UWF retinal mosaic. 200° field of view. 1924 by 1556 pixels:
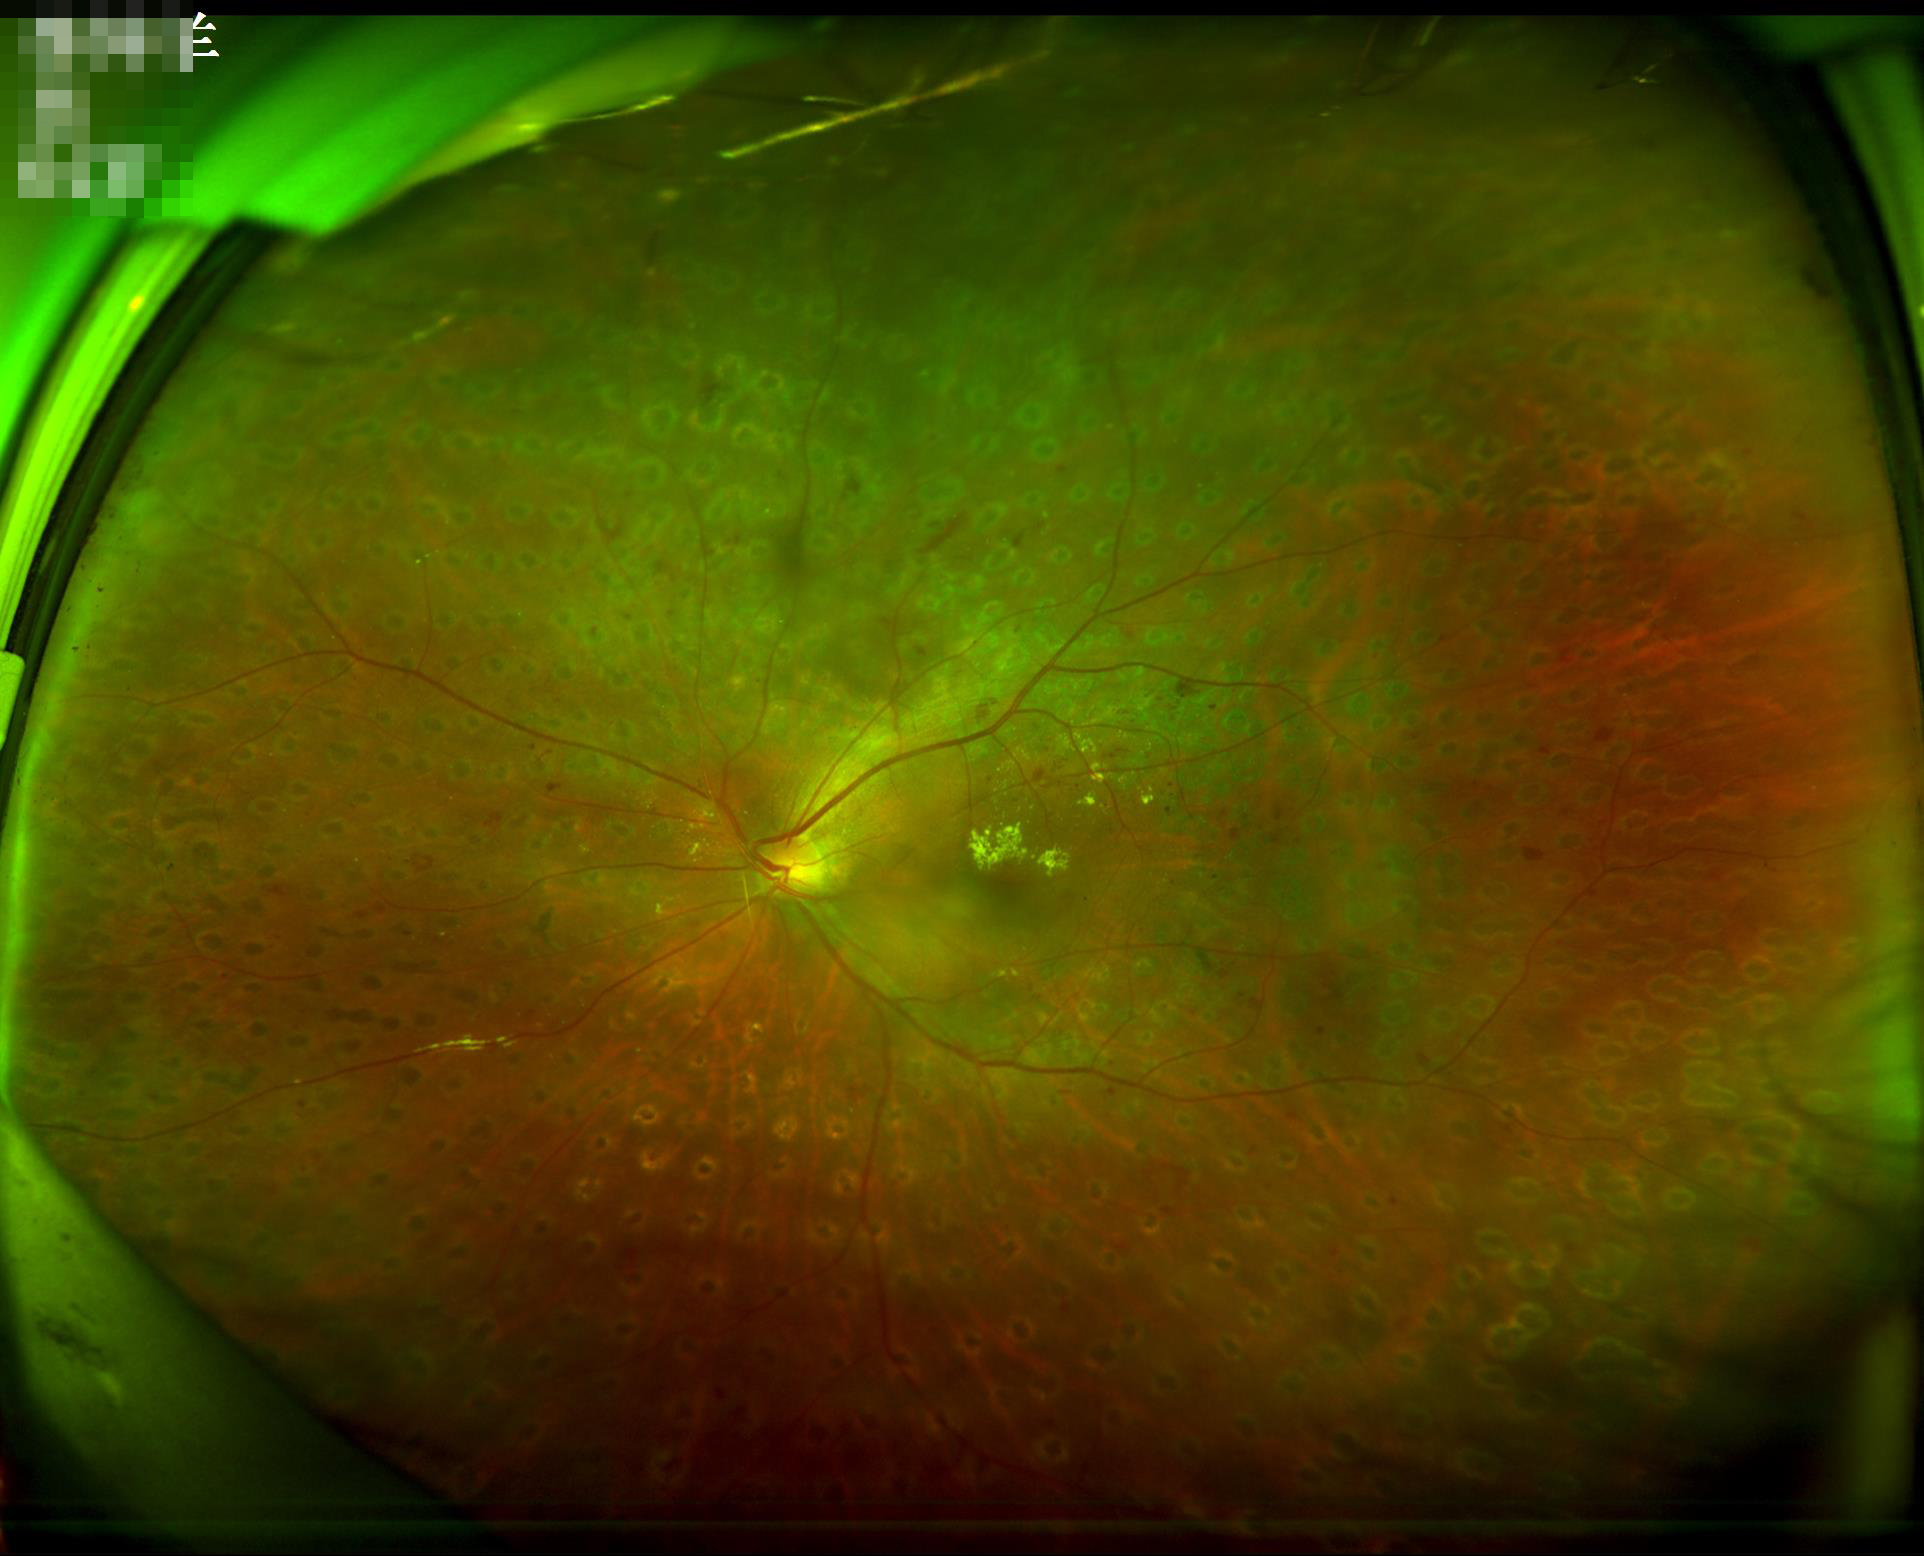 Sharpness = clear | Contrast = adequate | Illumination/color = adequate.